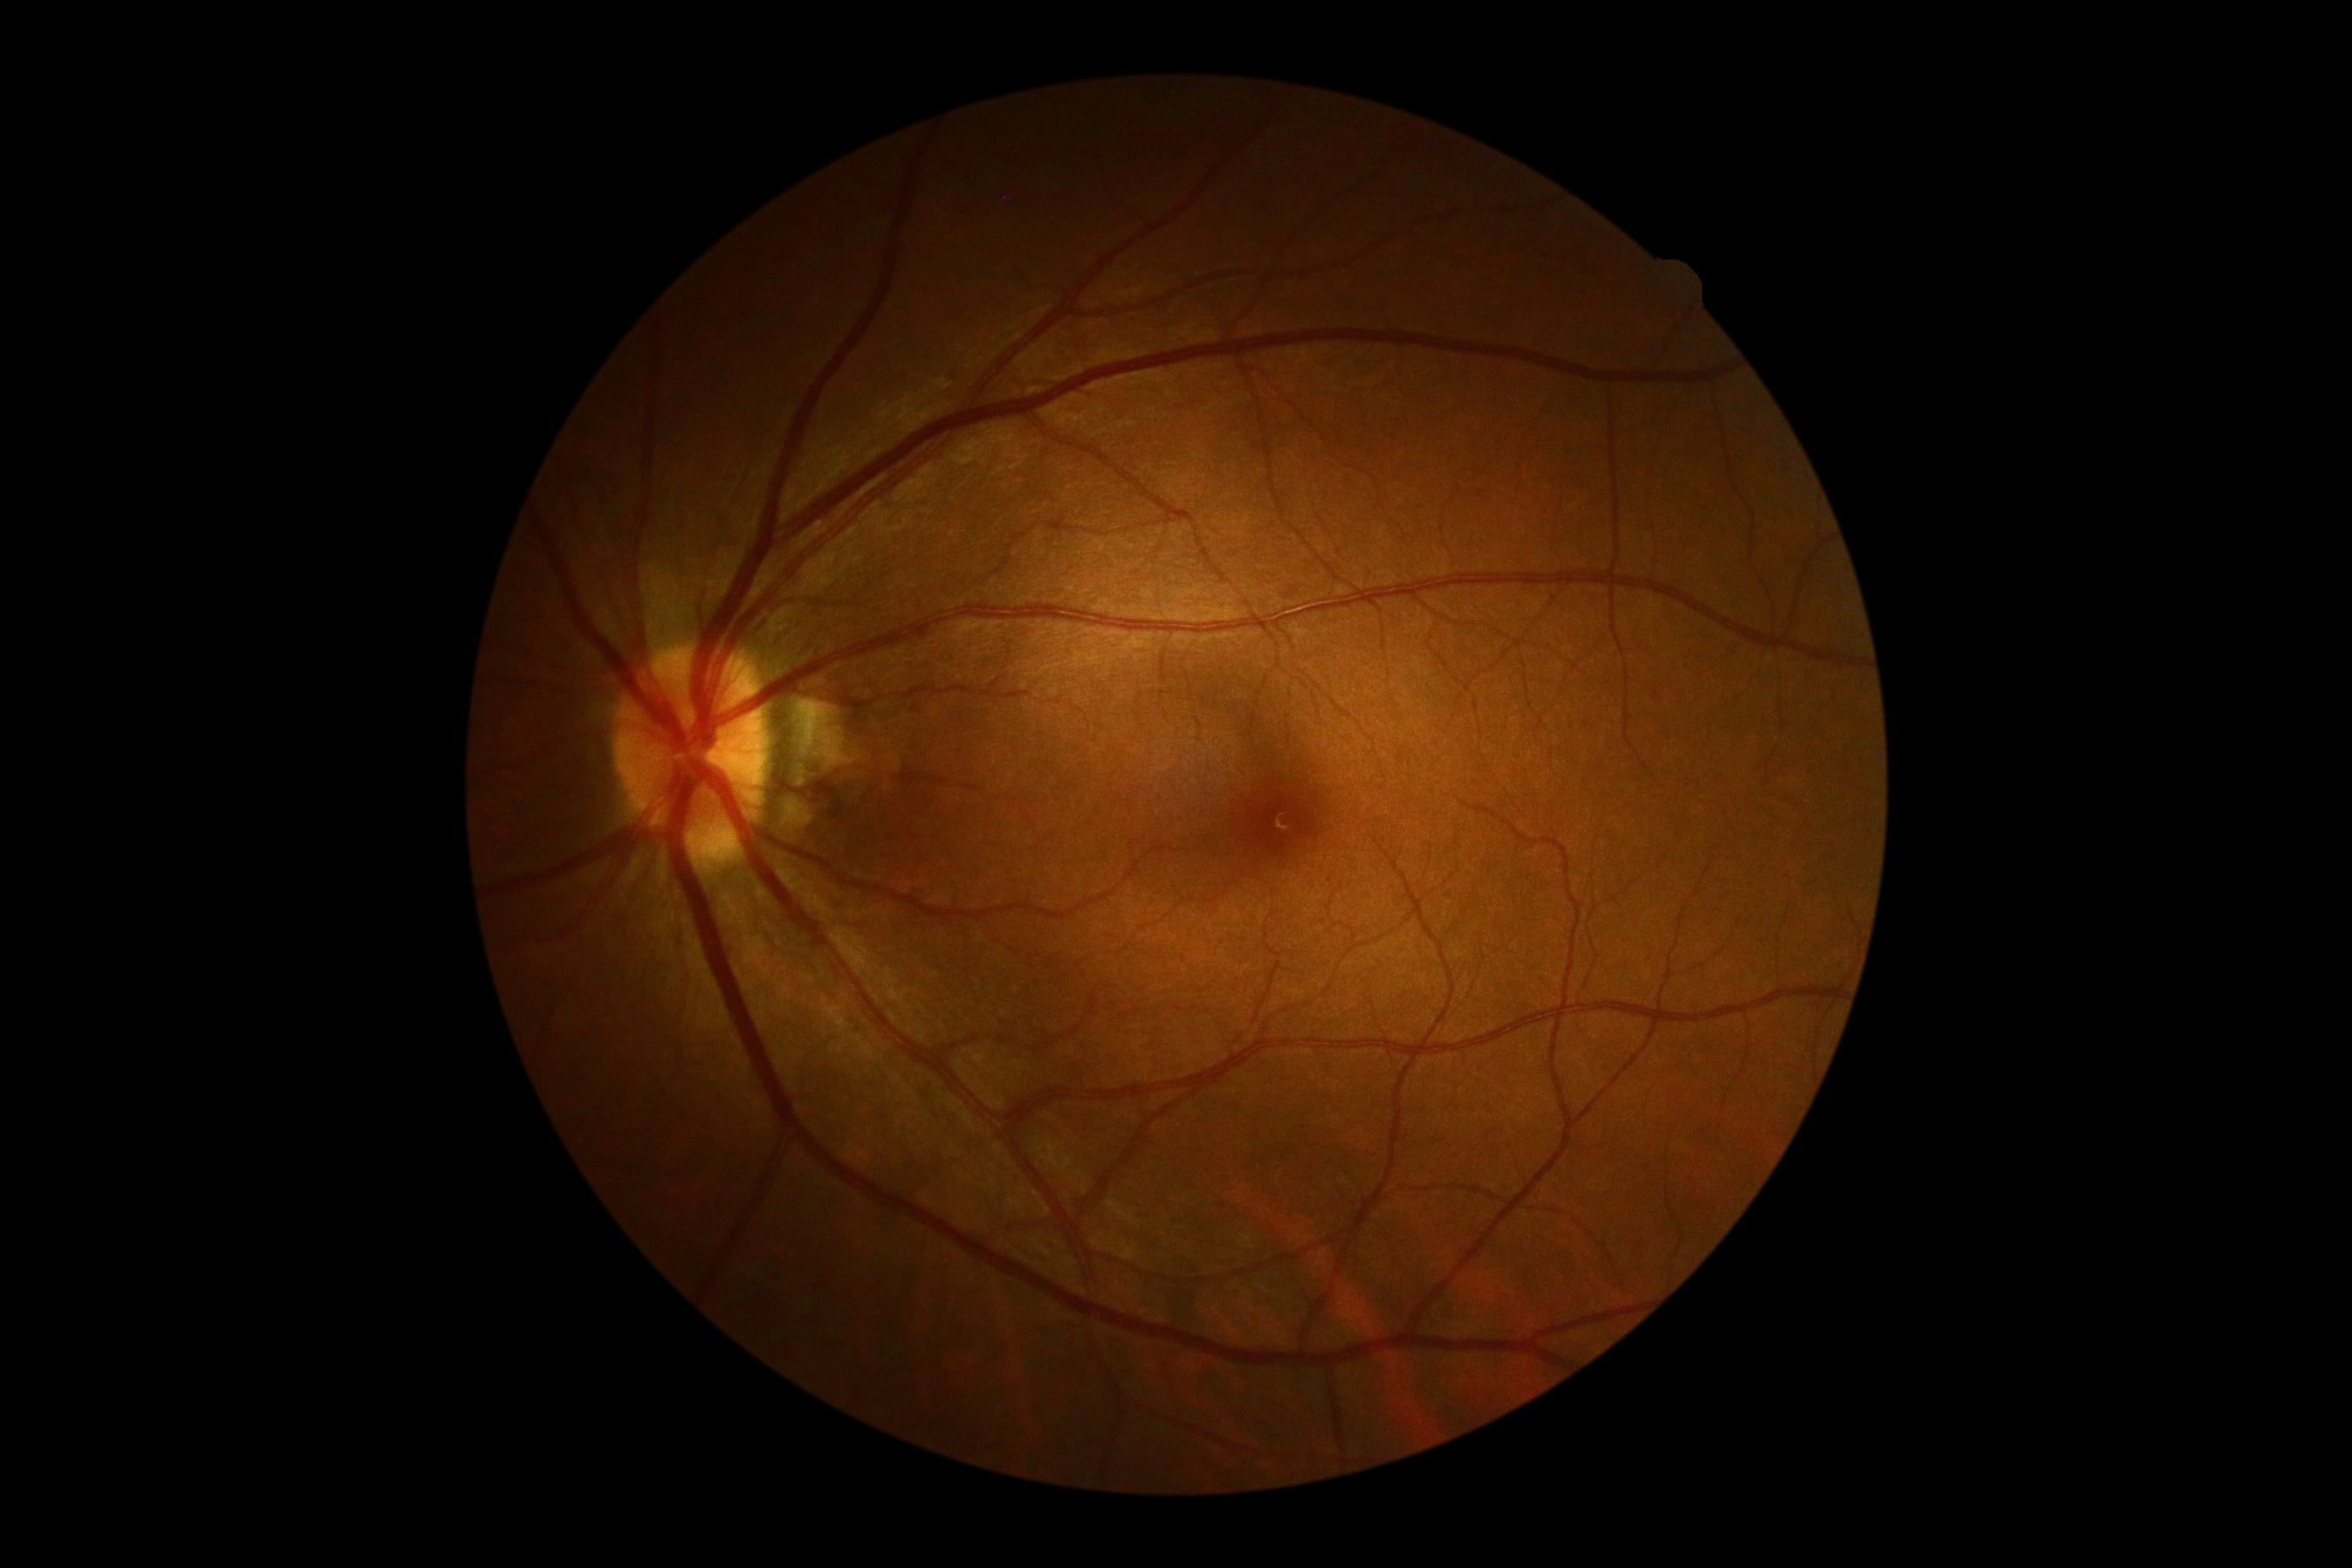

DR grade is no apparent diabetic retinopathy (0).